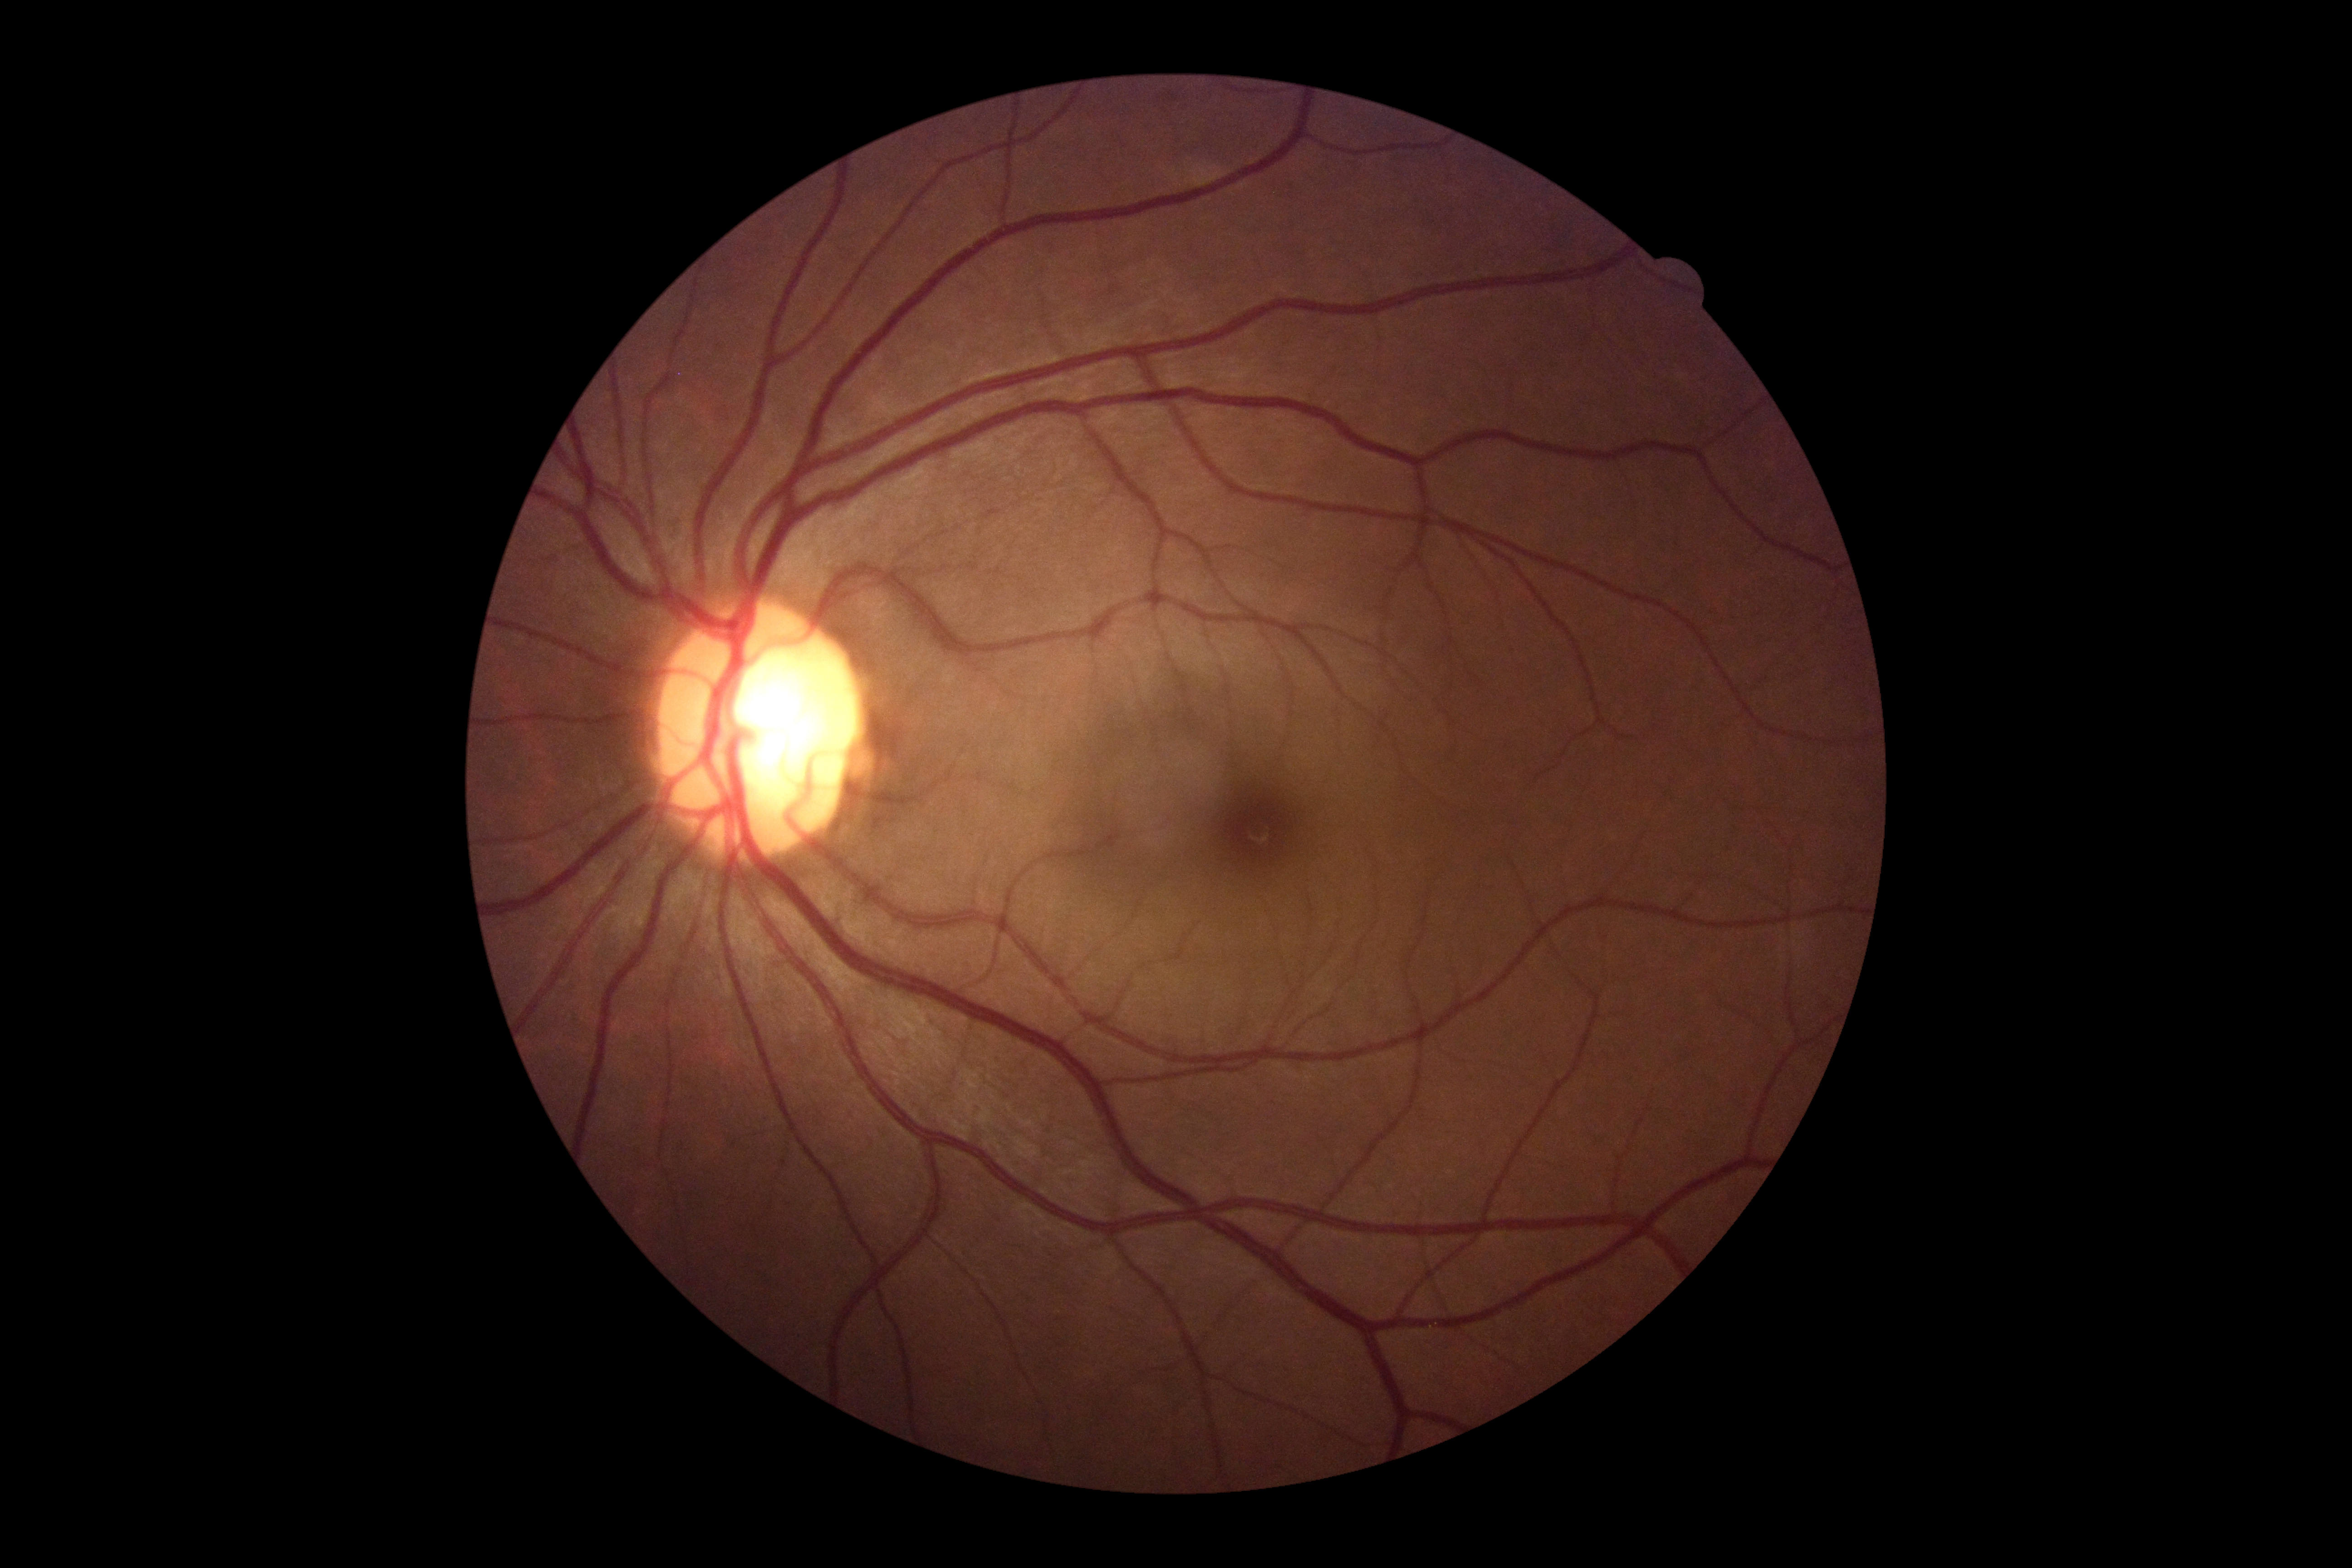 Findings:
• DR impression — no signs of DR
• DR — 0/4